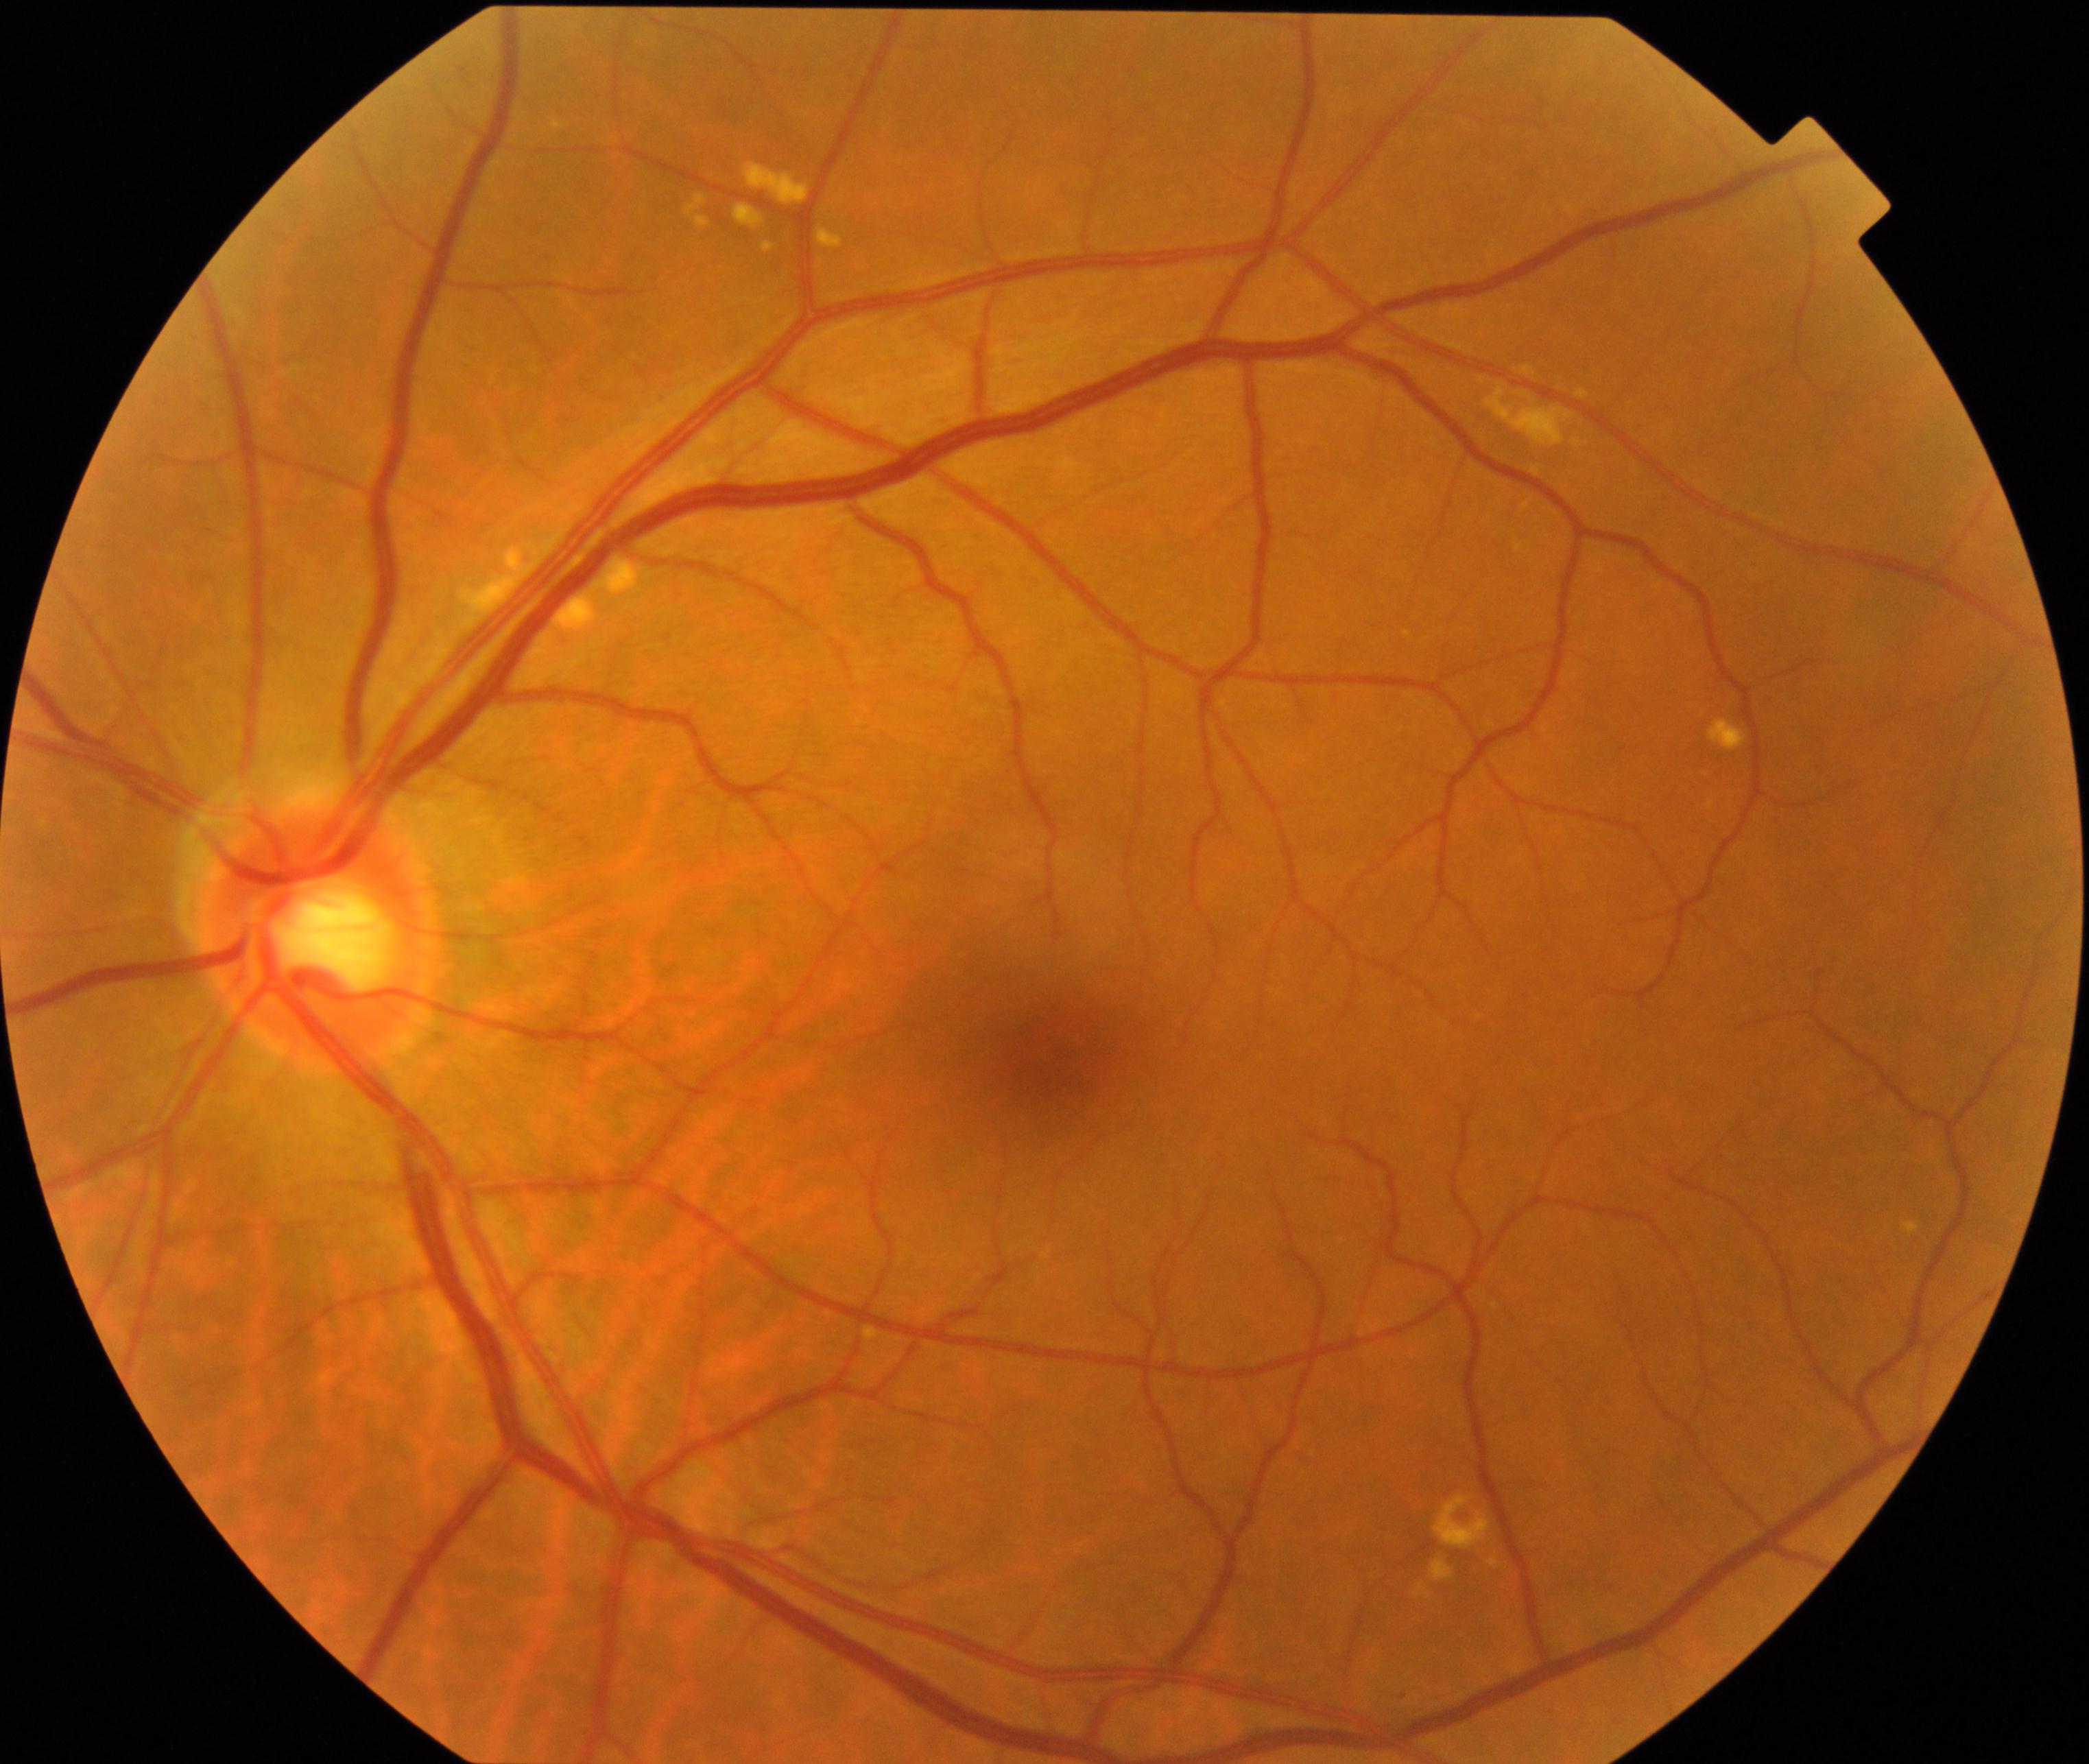

Impression: yellow-white spots or flecks. Typically showing multiple, discrete, yellow-white round dots or polymorphous fleck lesions, including early age-related macular degeneration (drusen <125 µm).